Captured with the Clarity RetCam 3 (130° field of view). Wide-field contact fundus photograph of an infant:
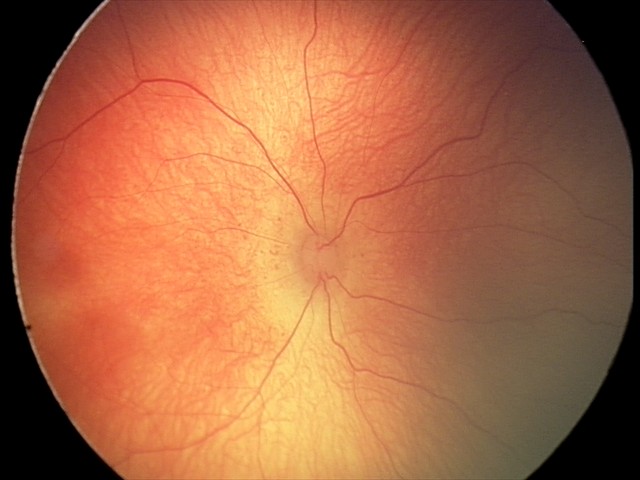 Plus disease absent. Screening series with retinopathy of prematurity stage 2.